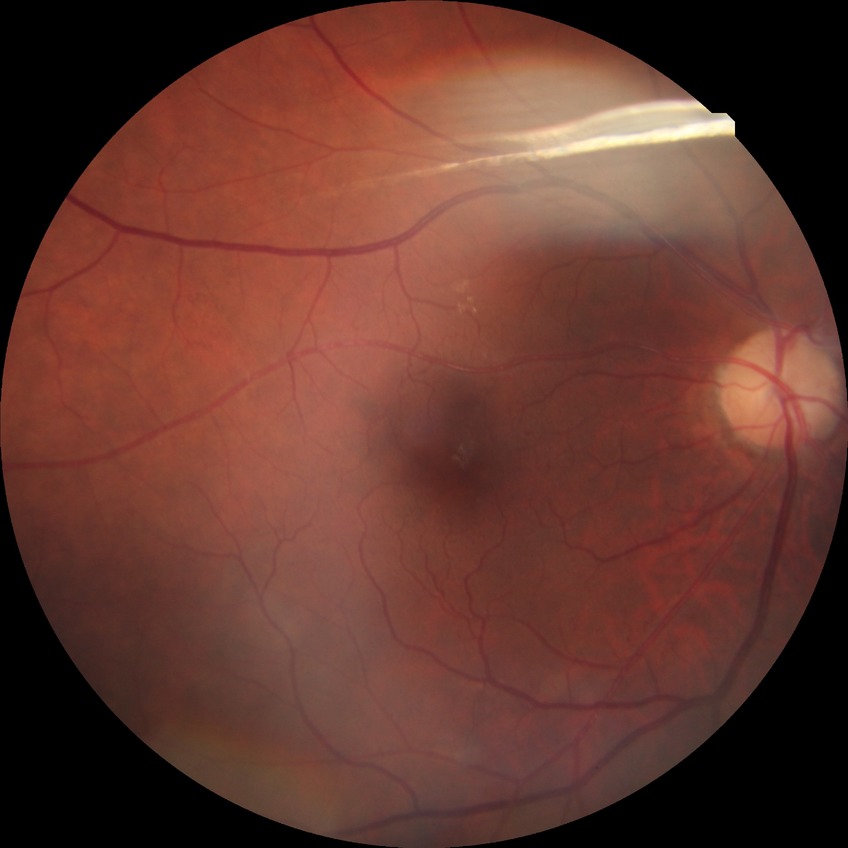 Diabetic retinopathy (DR): pre-proliferative diabetic retinopathy (PPDR).